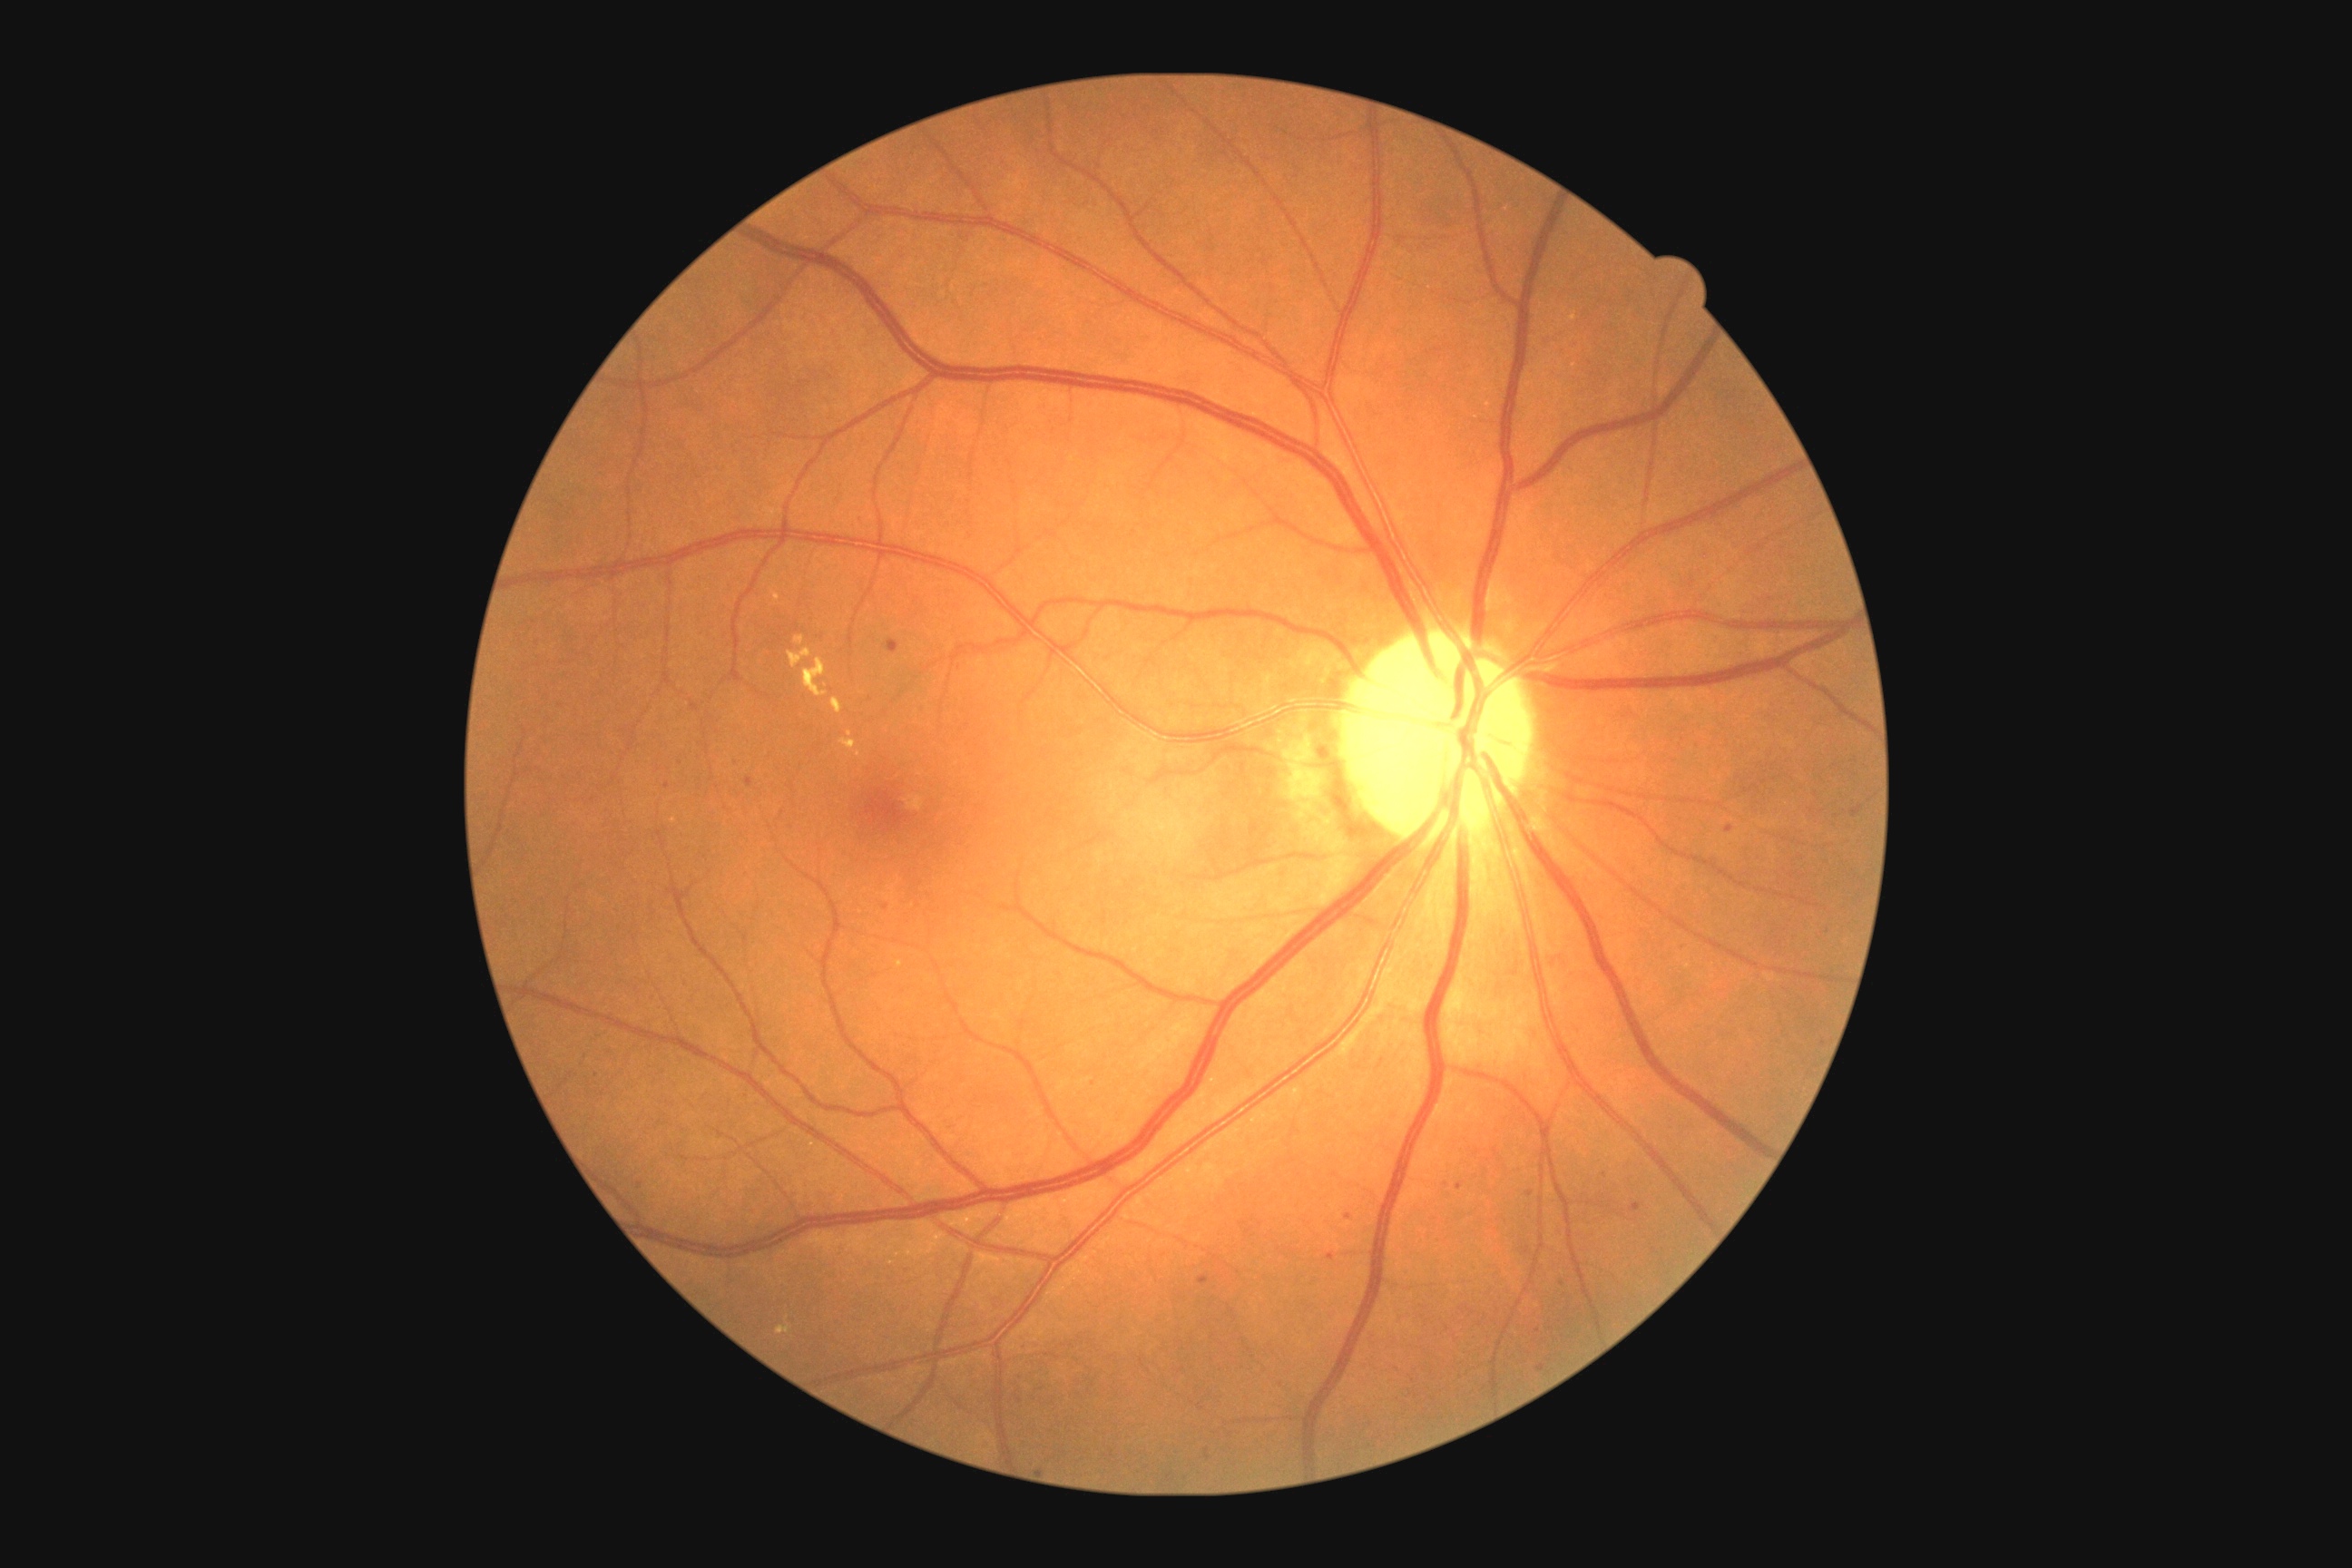

Diabetic retinopathy severity is moderate non-proliferative diabetic retinopathy (grade 2)
Representative lesions:
microaneurysms (subset): Rect(1206, 1449, 1211, 1460); Rect(1631, 1202, 1642, 1213); Rect(1199, 1277, 1210, 1286); Rect(1328, 1253, 1335, 1262)
Additional small microaneurysms near (1538; 1331); (1530; 1194); (909; 1274); (1249; 1232); (1605; 1175); (1496; 1152); (886; 907); (640; 1186)